Non-mydriatic acquisition, 240 by 240 pixels: 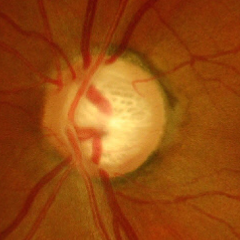

Q: Is glaucoma present?
A: Advanced glaucomatous optic neuropathy.